Modified Davis classification.
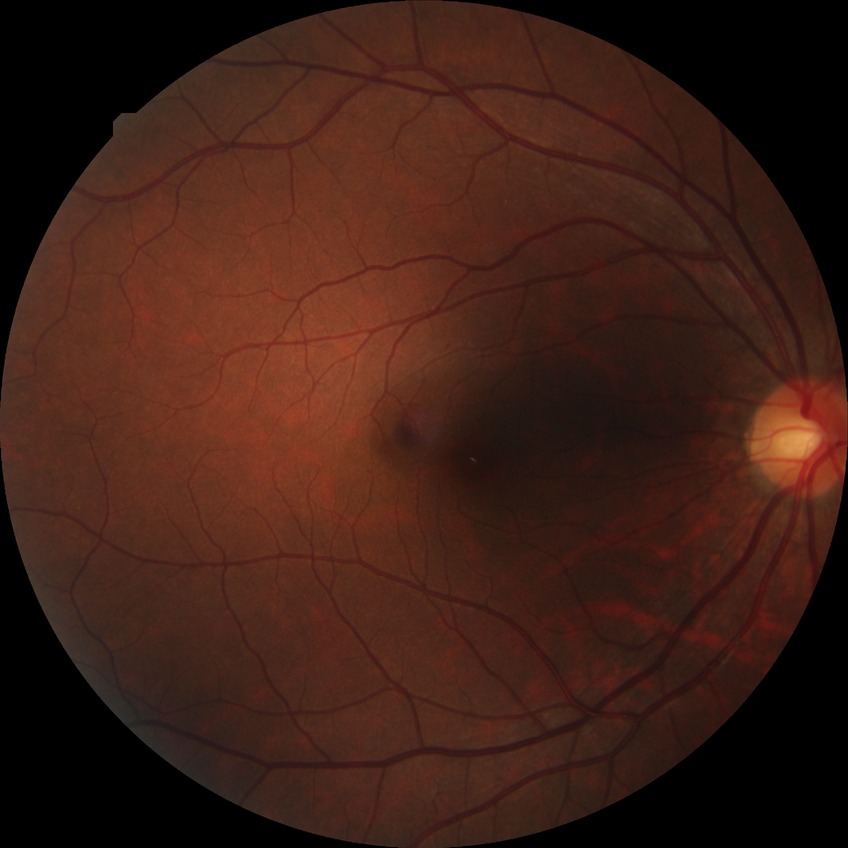 davis_grade: no diabetic retinopathy (NDR)